Acquired with a NIDEK AFC-230, 848x848, 45 degree fundus photograph, Davis DR grading, without pupil dilation, color fundus image
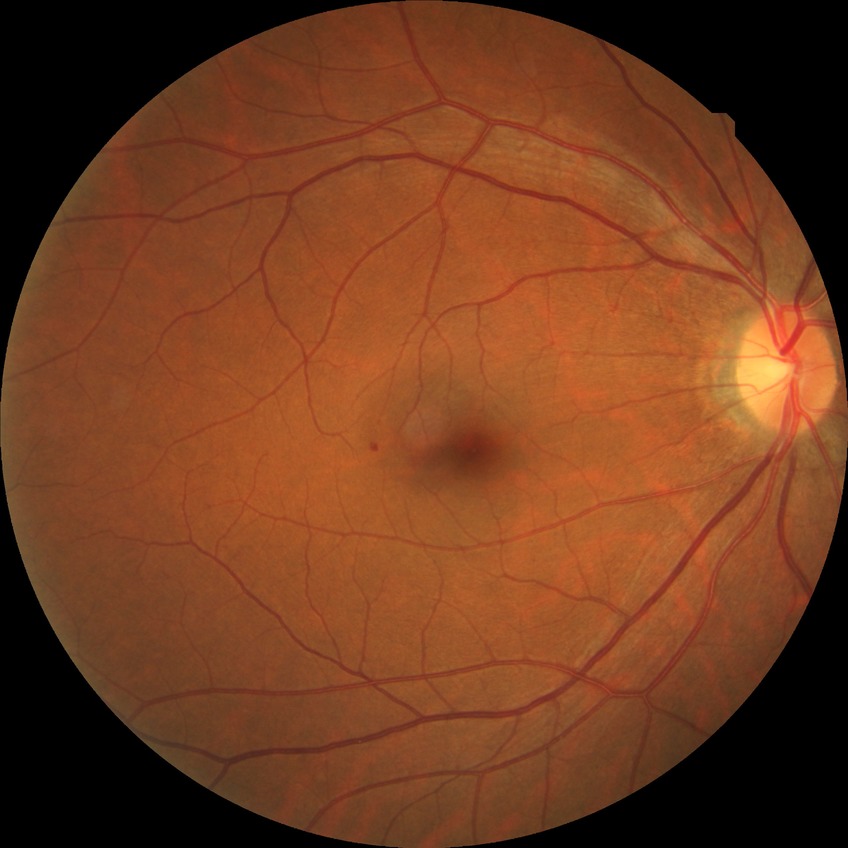
Findings:
• diabetic retinopathy (DR) — SDR (simple diabetic retinopathy)